1659 by 2212 pixels — 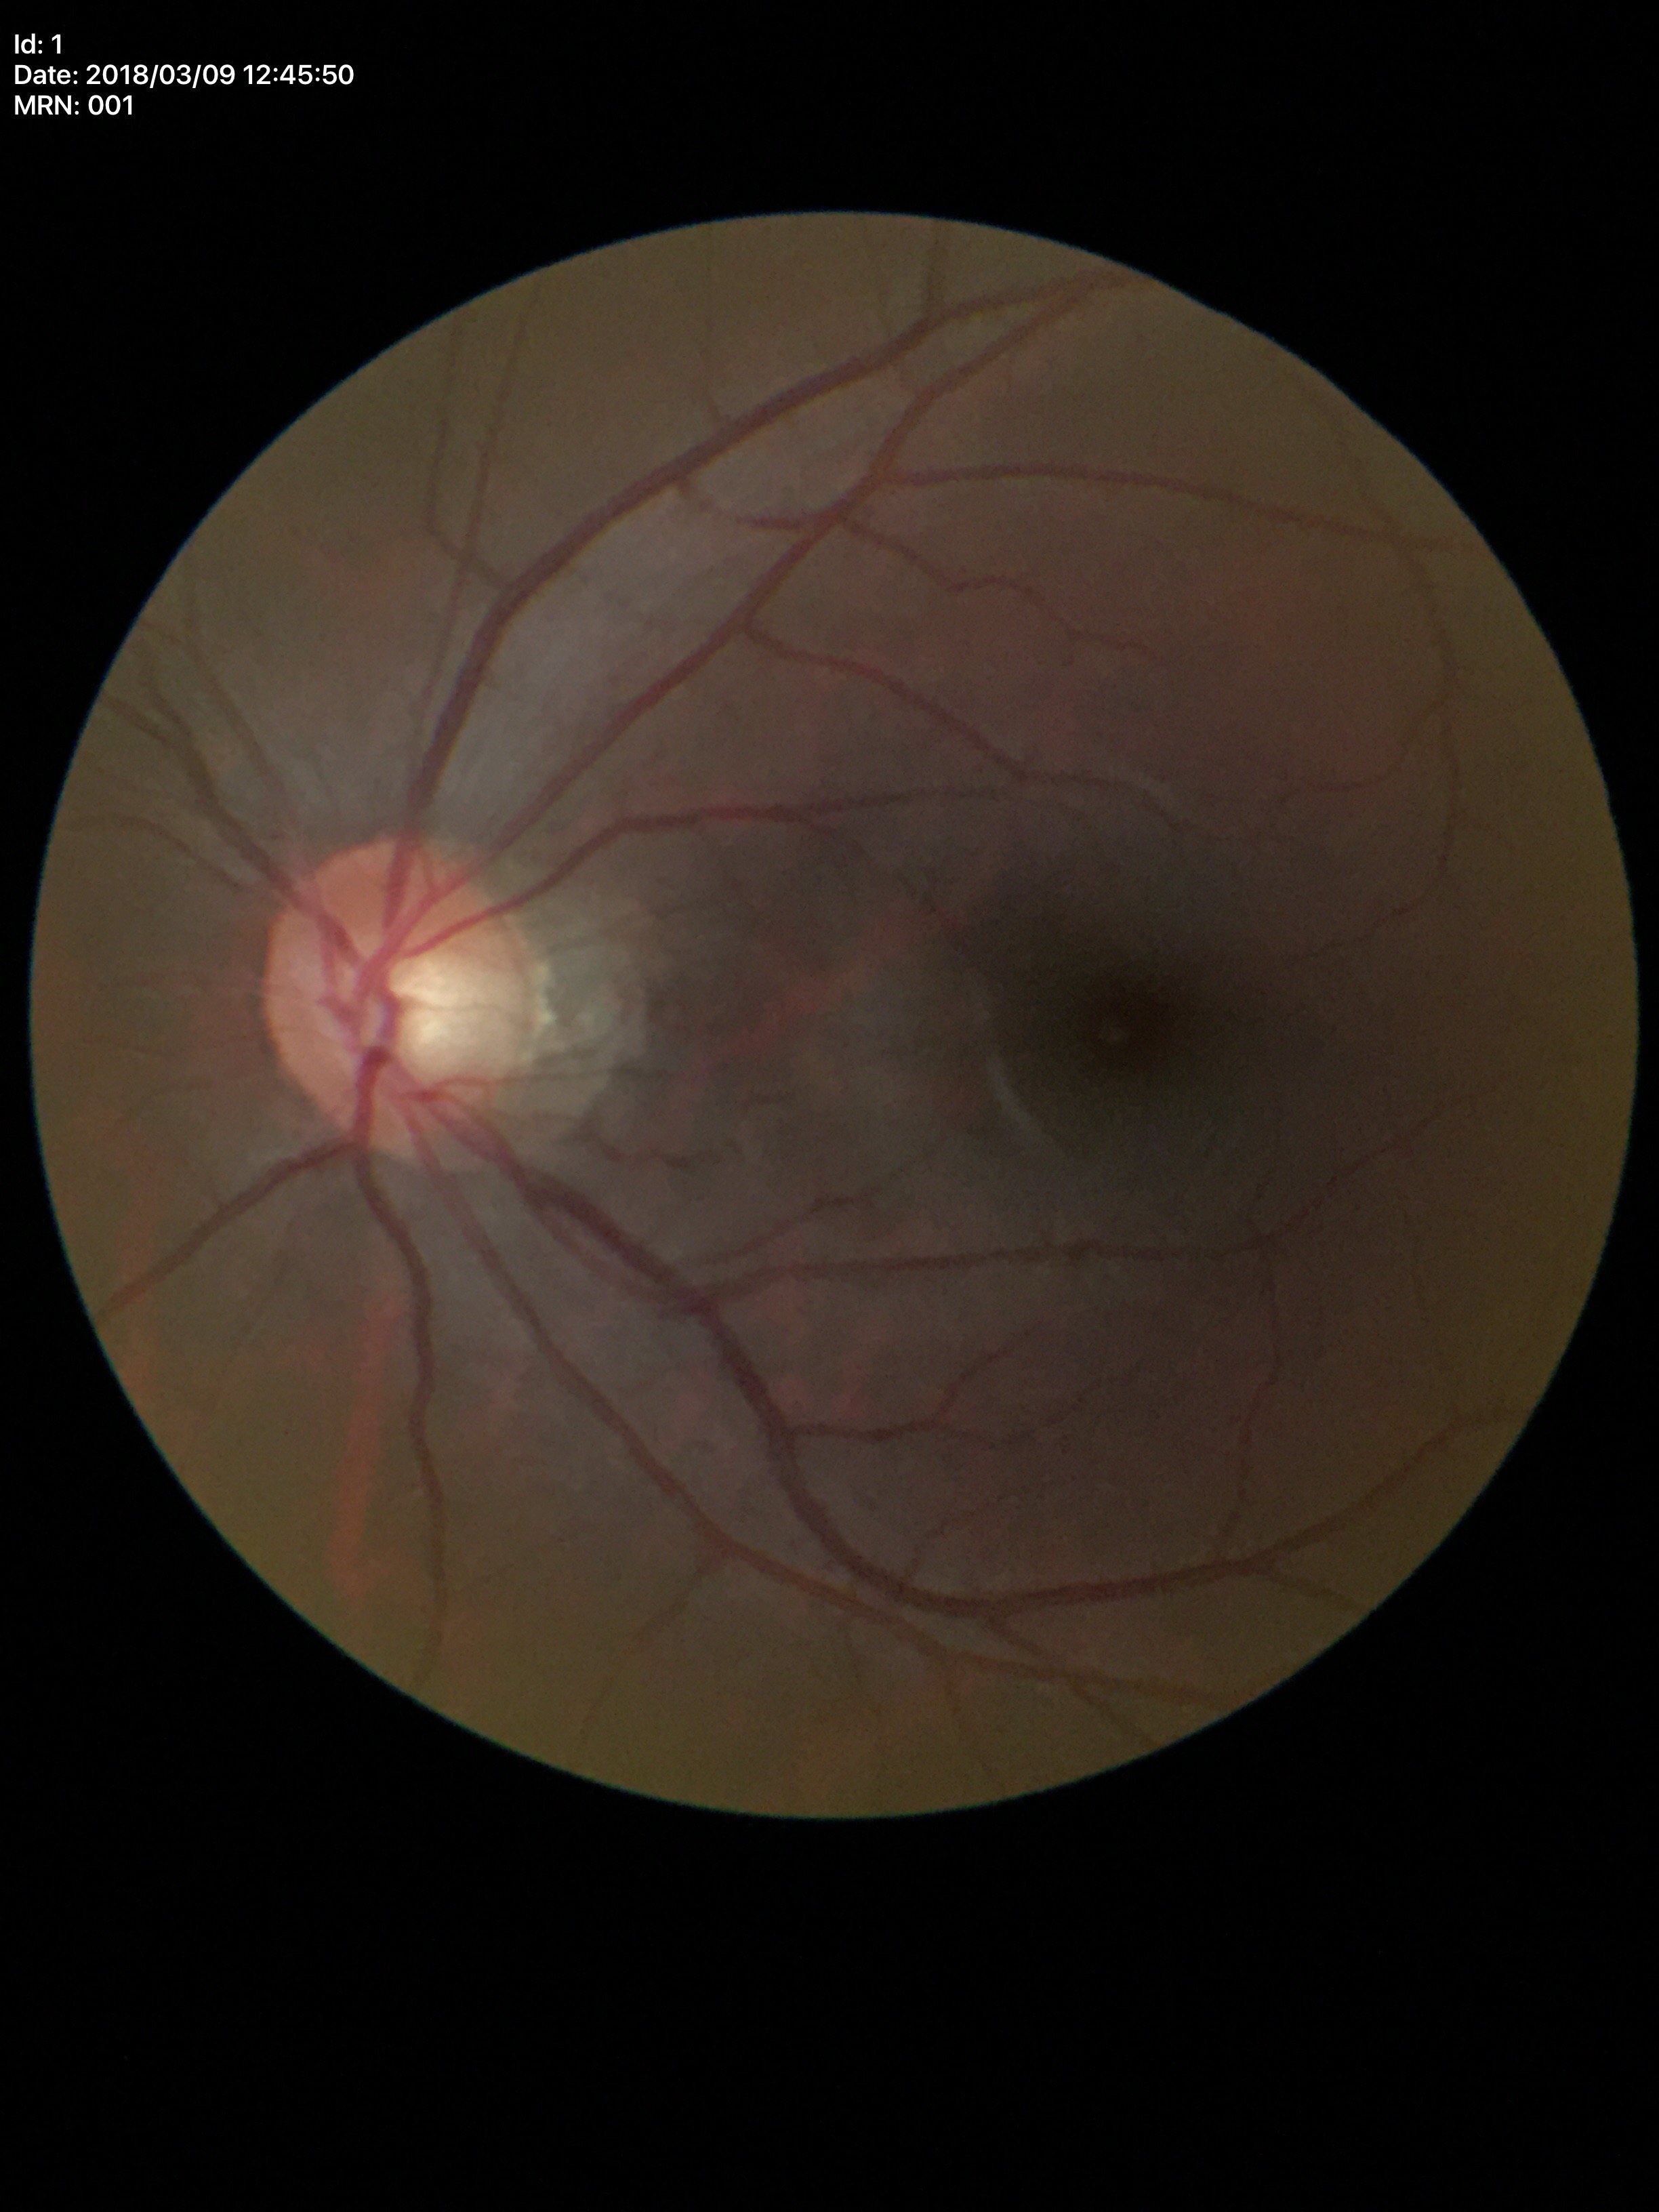
No glaucomatous findings (1/5 graders called glaucoma suspect). Area CDR: 0.30. Vertical cup-to-disc ratio is 0.53.